Pediatric wide-field fundus photograph.
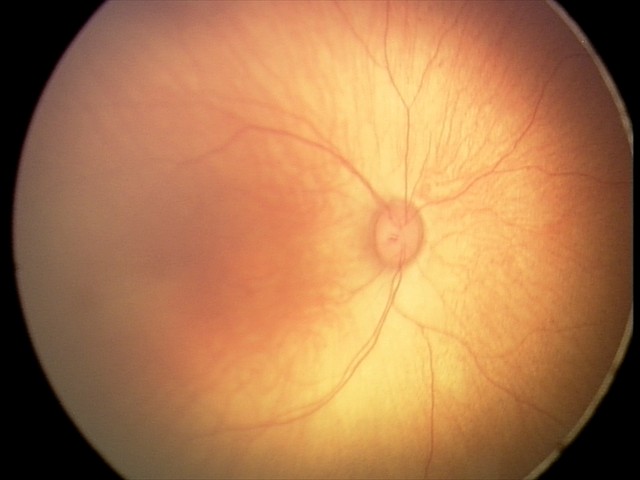
Series diagnosed as retinal hemorrhages.